Wide-field fundus image from infant ROP screening. Acquired on the Phoenix ICON — 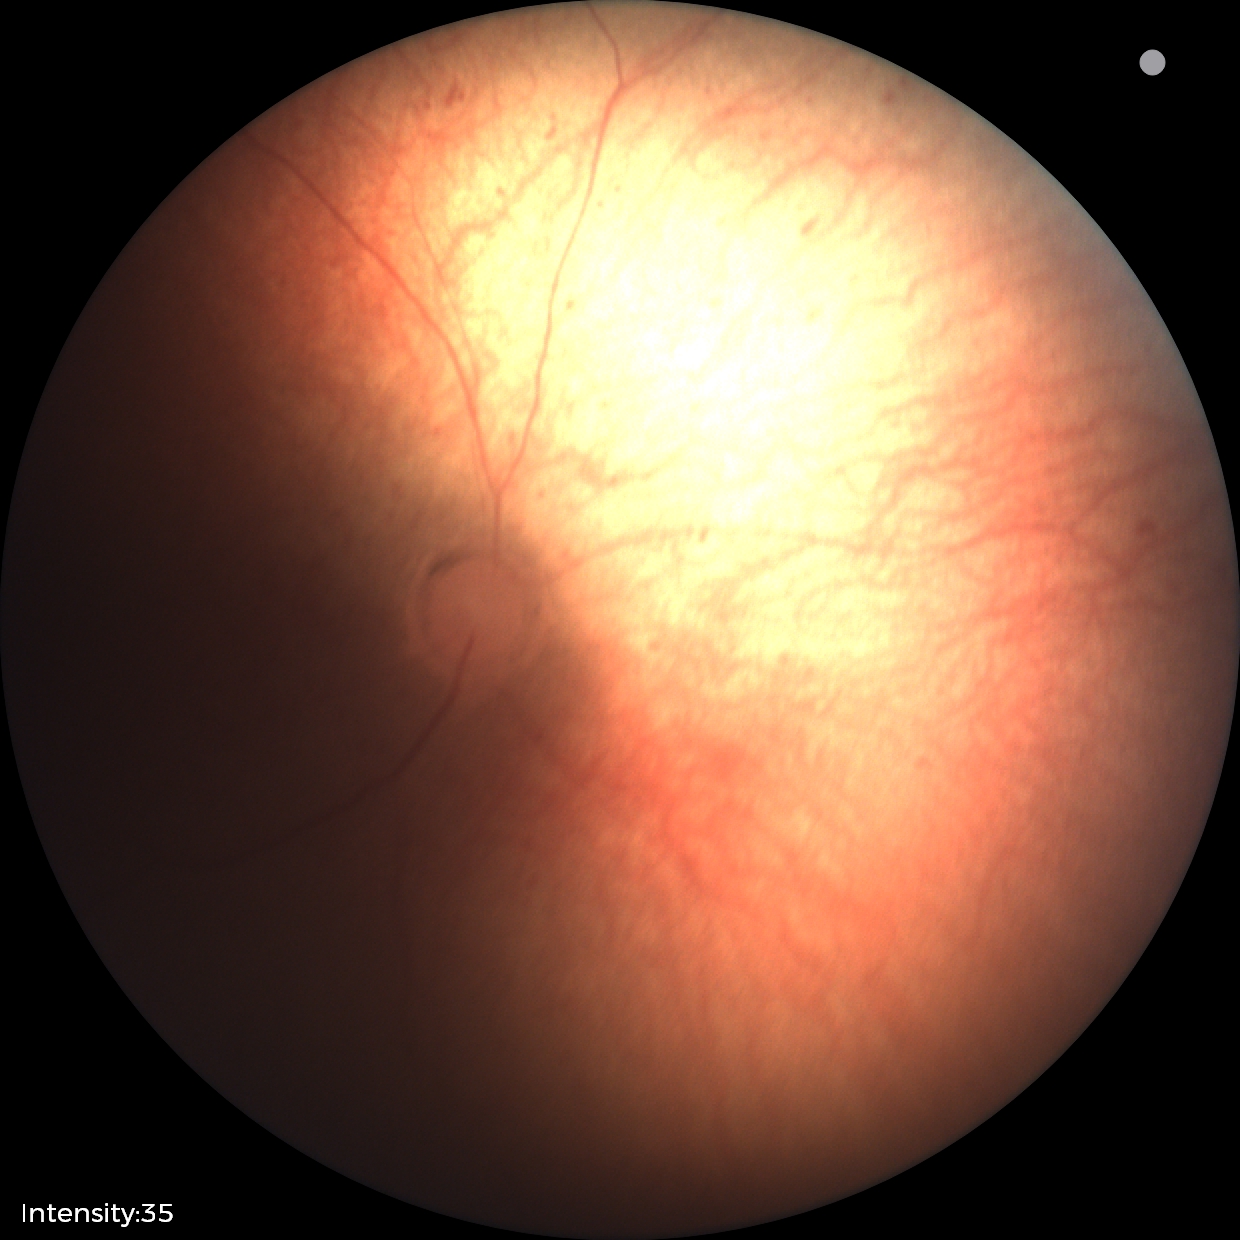
Series diagnosed as retinopathy of prematurity (ROP) stage 1. No plus disease.